45° FOV
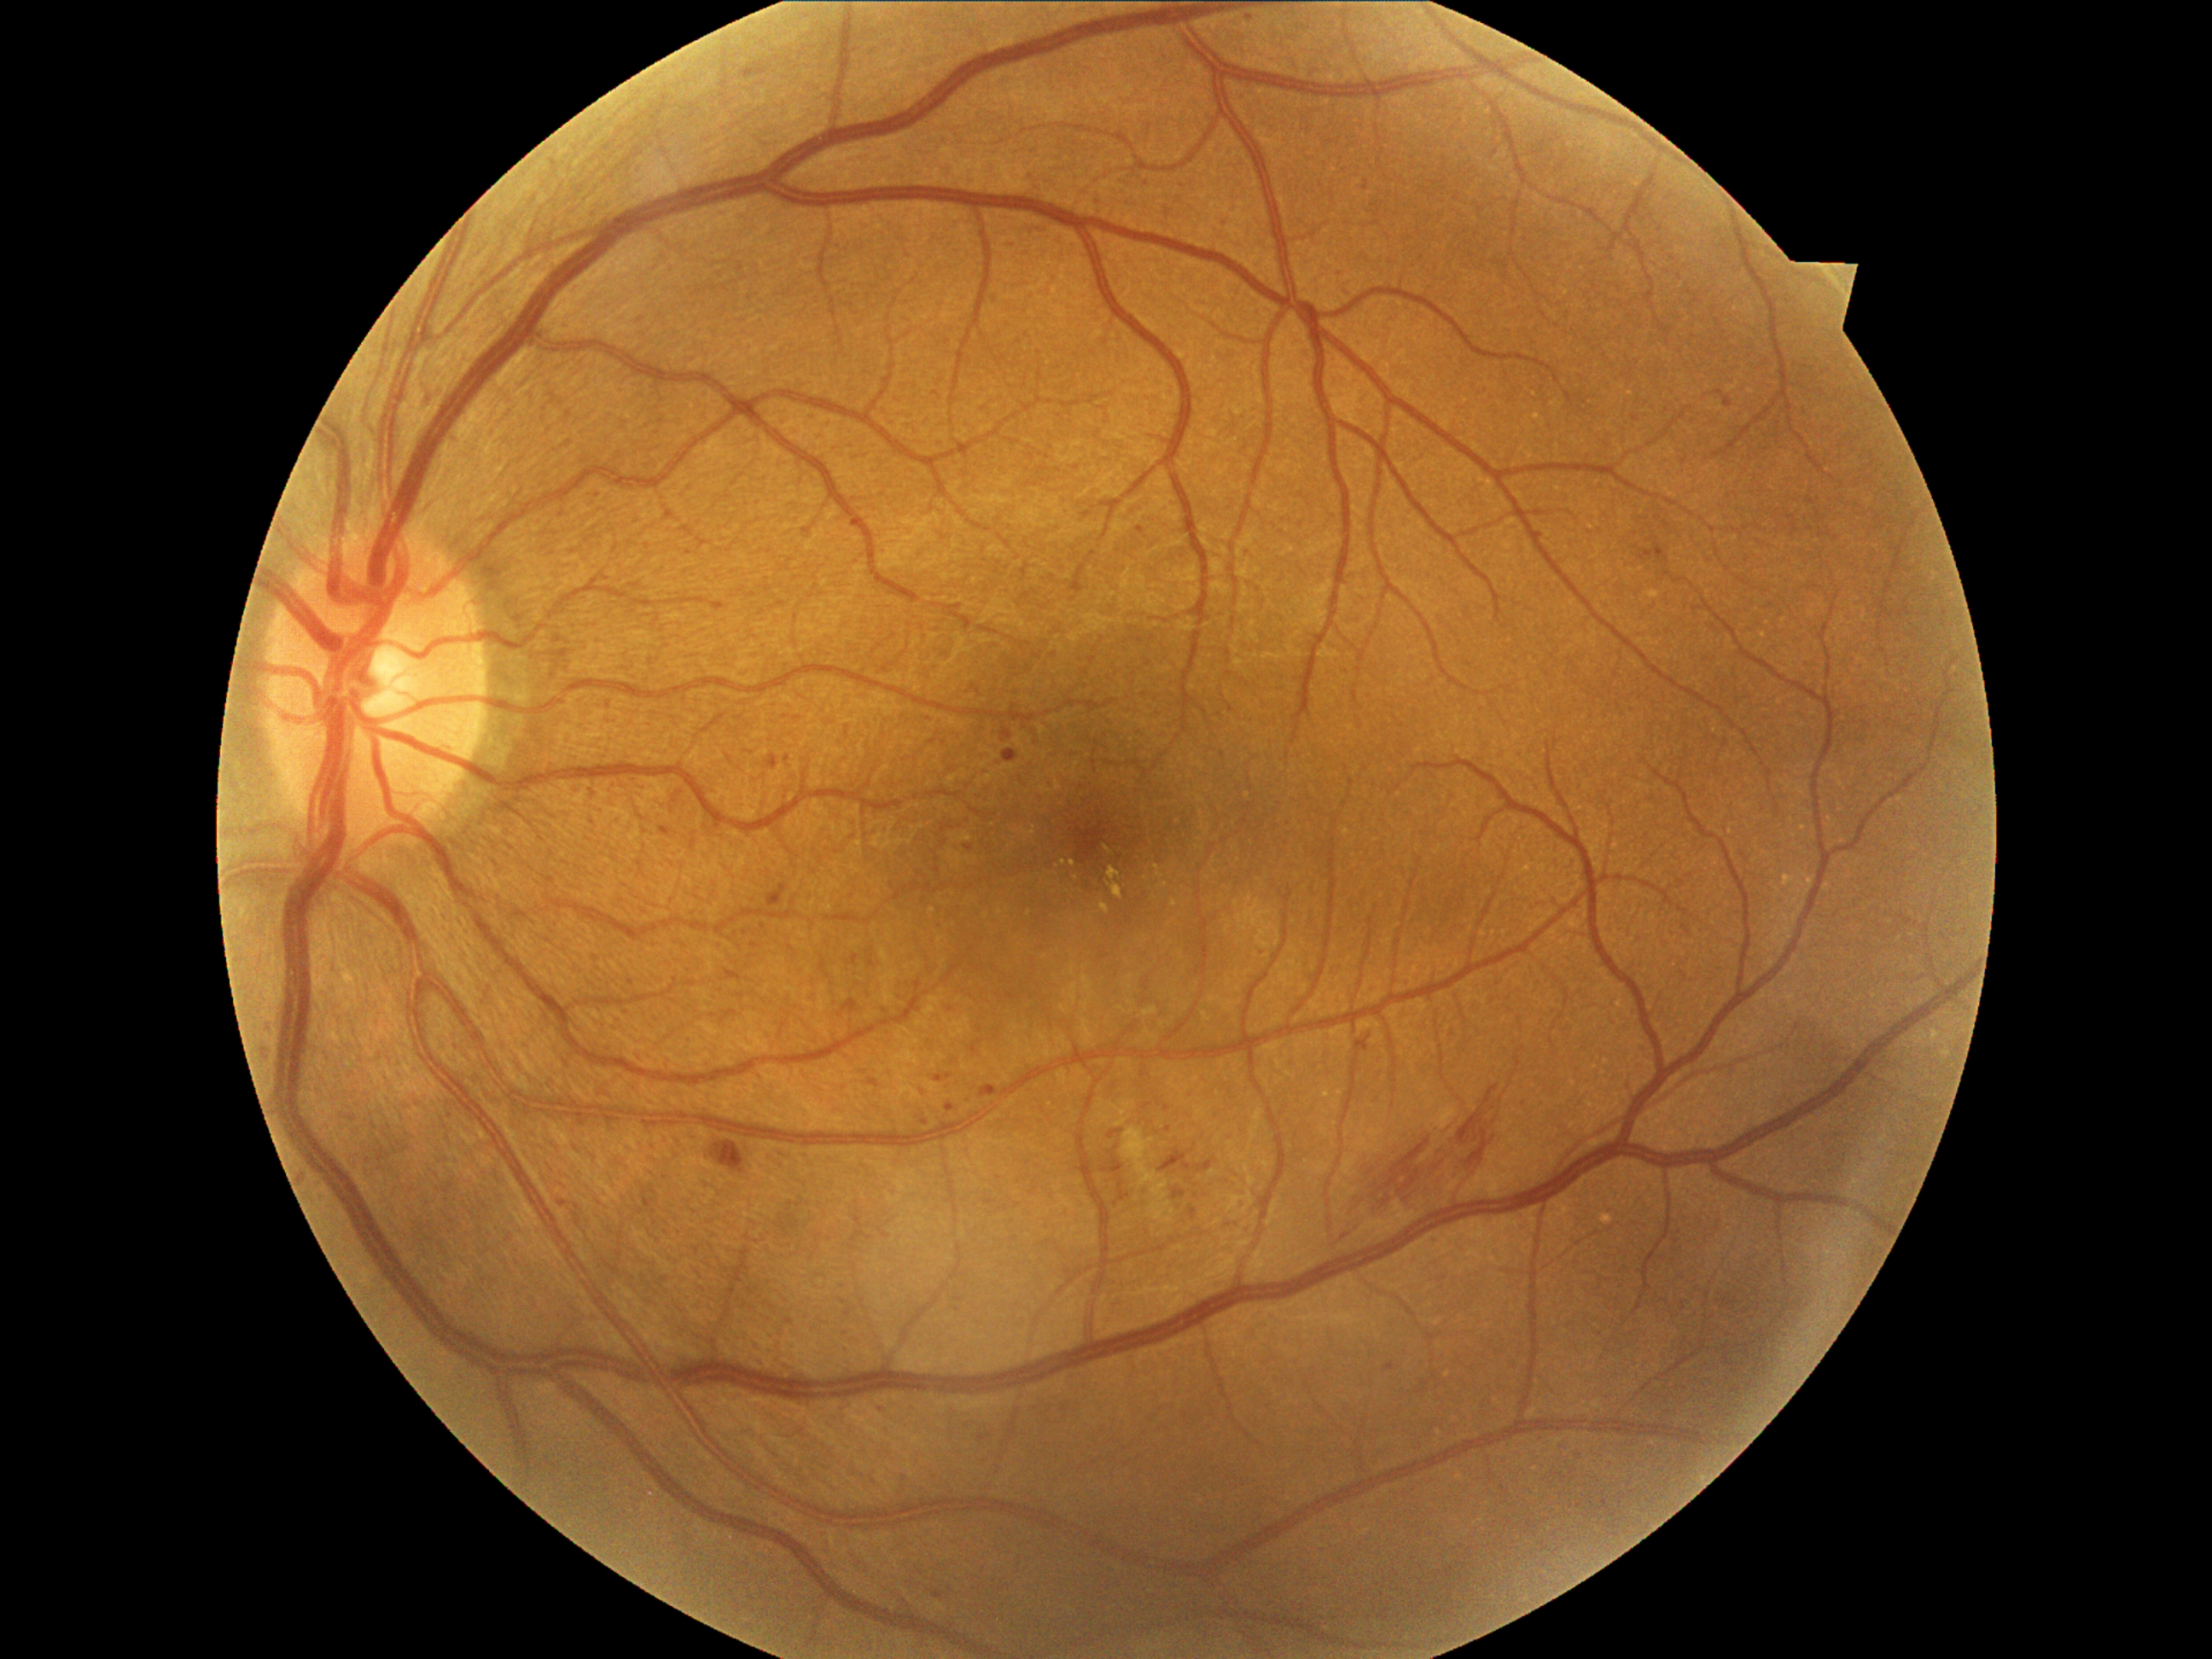
{"partial": true, "dr_grade": 2, "lesions": {"ma": [[260, 1051, 271, 1056], [1662, 549, 1667, 559], [1001, 728, 1013, 743], [979, 1435, 986, 1443], [1173, 1189, 1185, 1201], [1365, 180, 1371, 192], [981, 1085, 999, 1098], [1148, 178, 1151, 192], [934, 1592, 945, 1598], [1109, 1131, 1122, 1139], [1102, 1160, 1126, 1173]], "ma_small_approx": [[1008, 244], [307, 1179], [788, 760]]}}